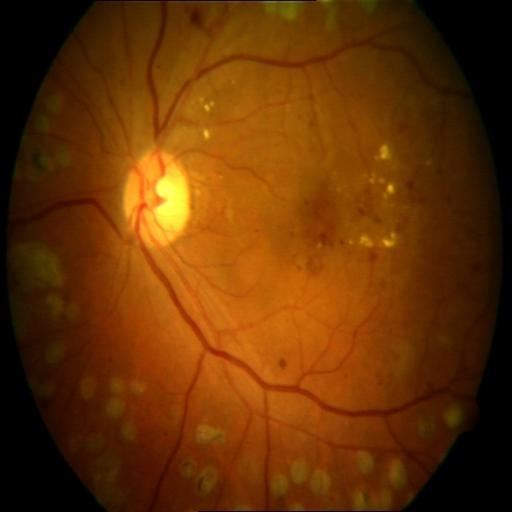
Retinal fundus photograph demonstrating hemorrhagic retinopathy (HR), laser scars (LS), microaneurysms (MCA) & exudation (EDN).